2089x1764px — 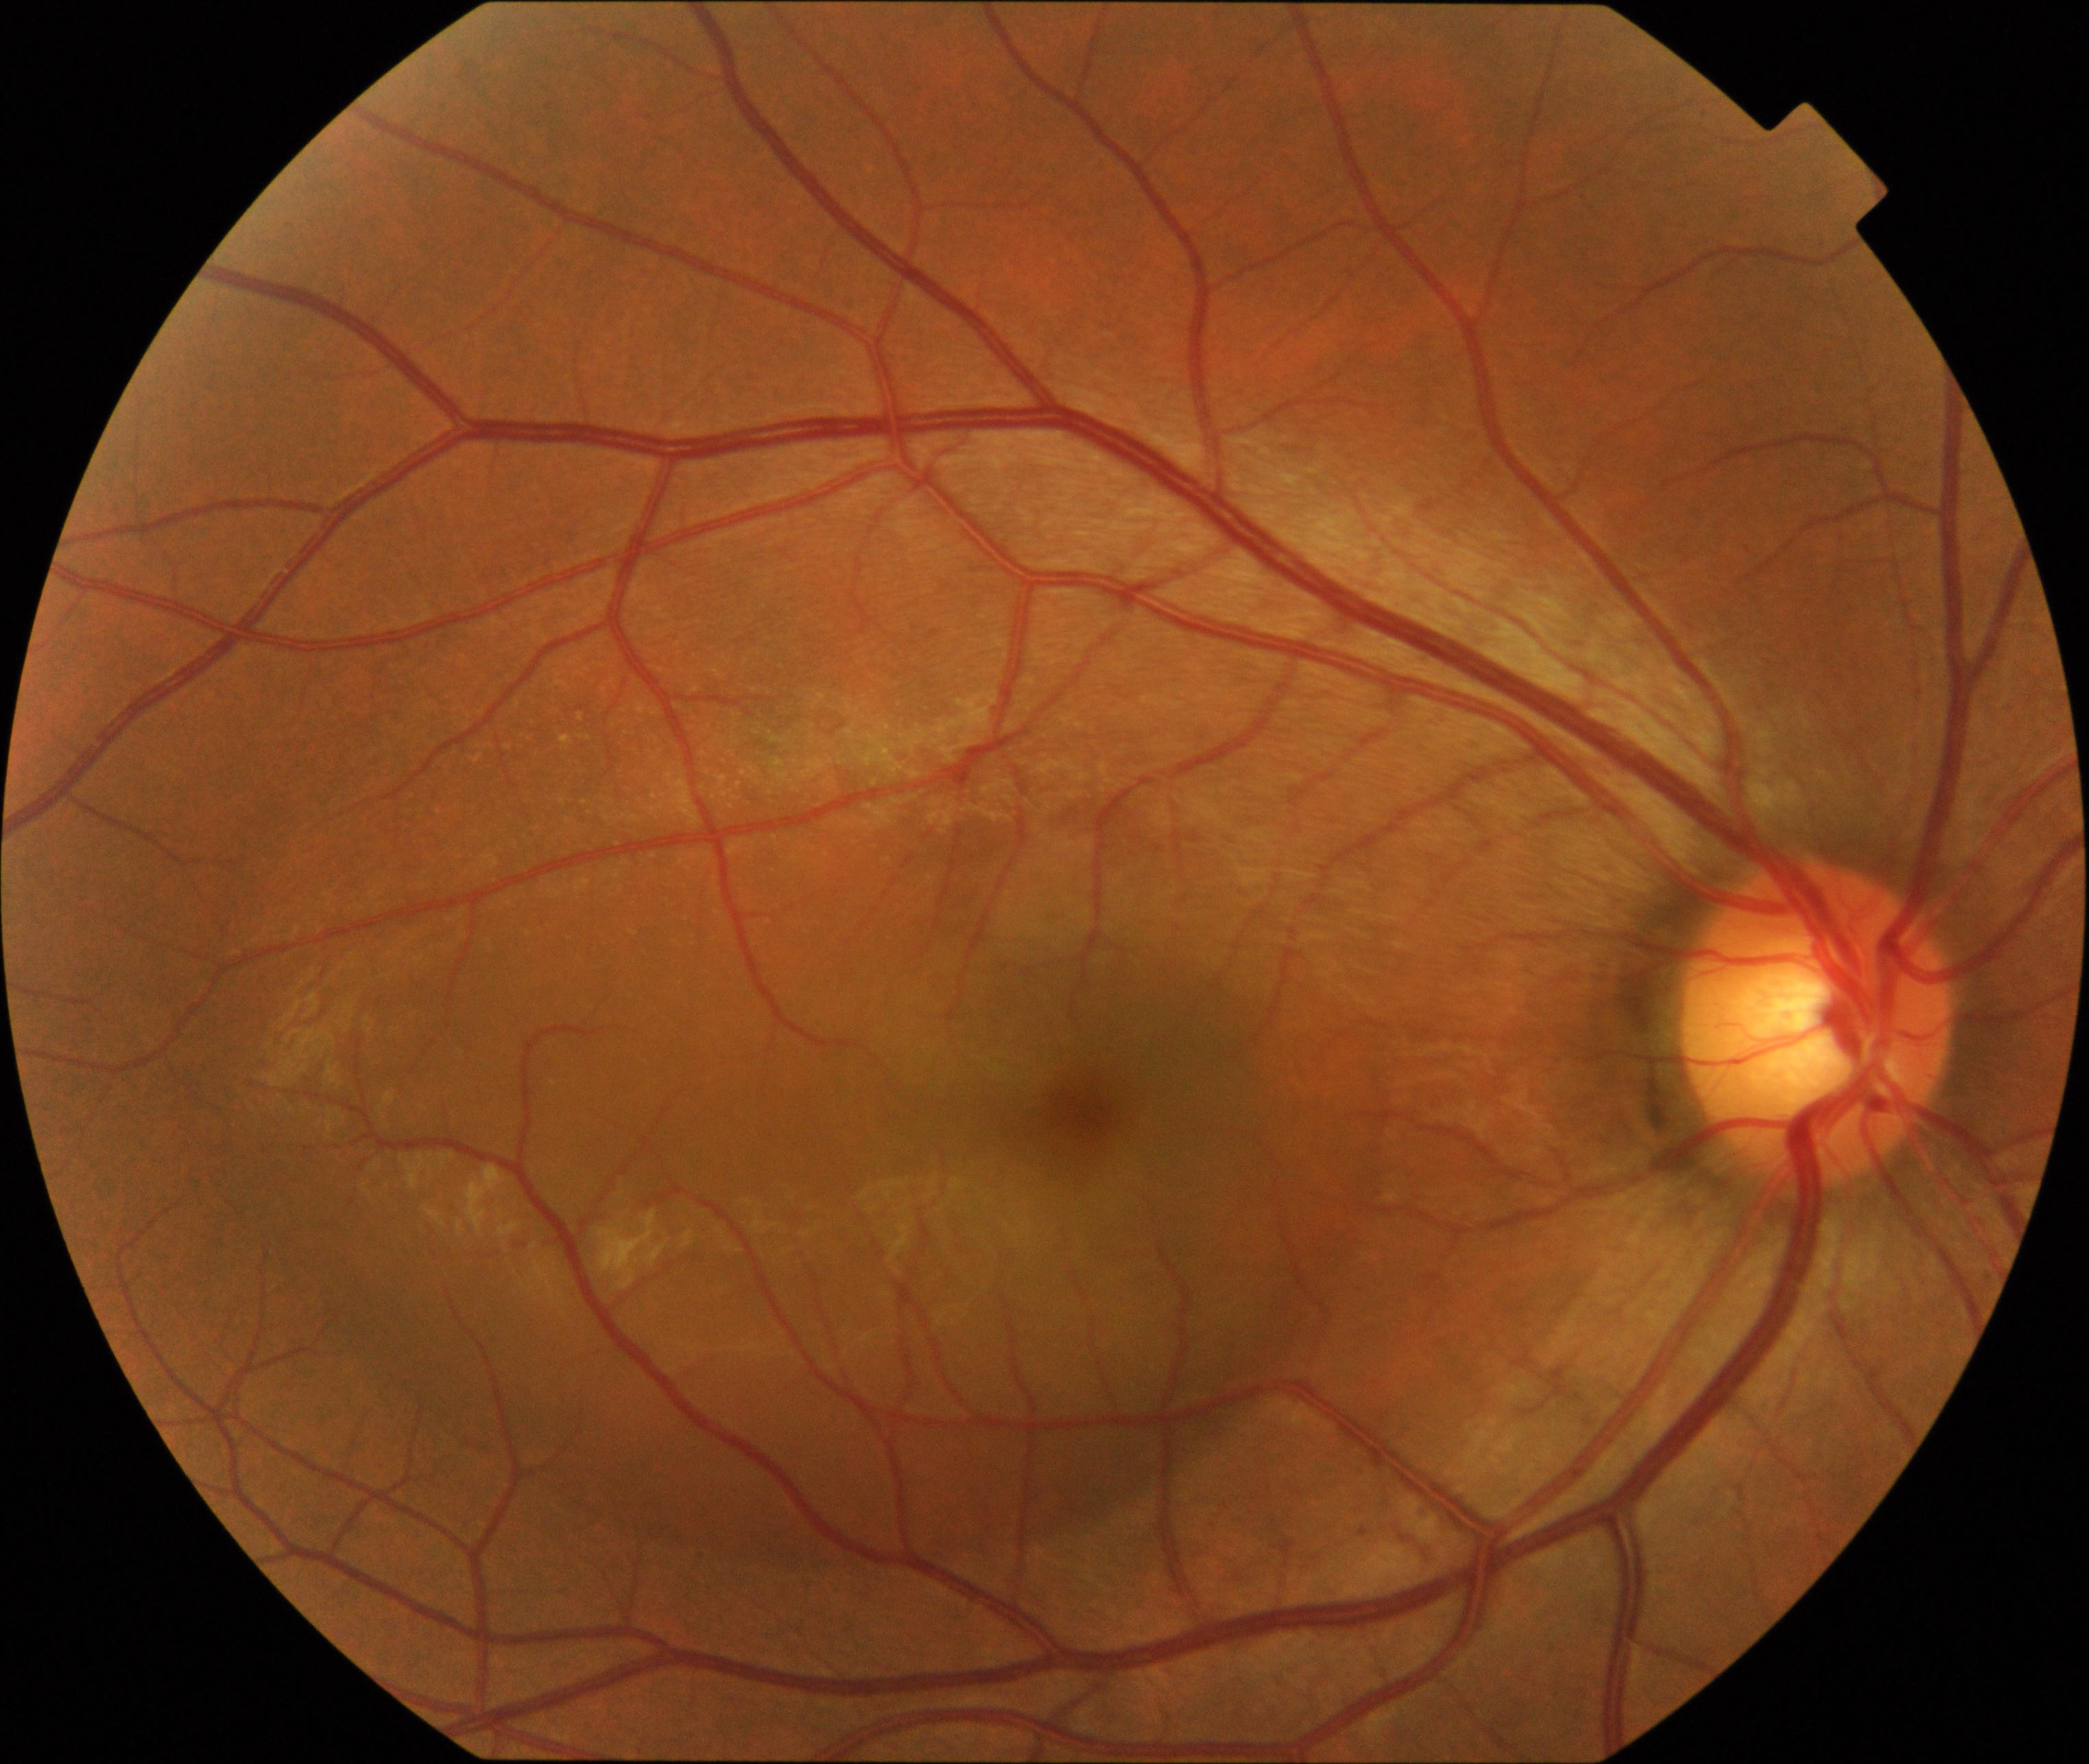

Findings: central serous chorioretinopathy (CSCR).